Non-mydriatic acquisition.
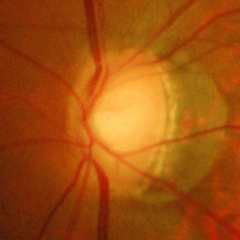
Impression = severe glaucomatous damage.